45-degree field of view. 1932 x 1910 pixels — 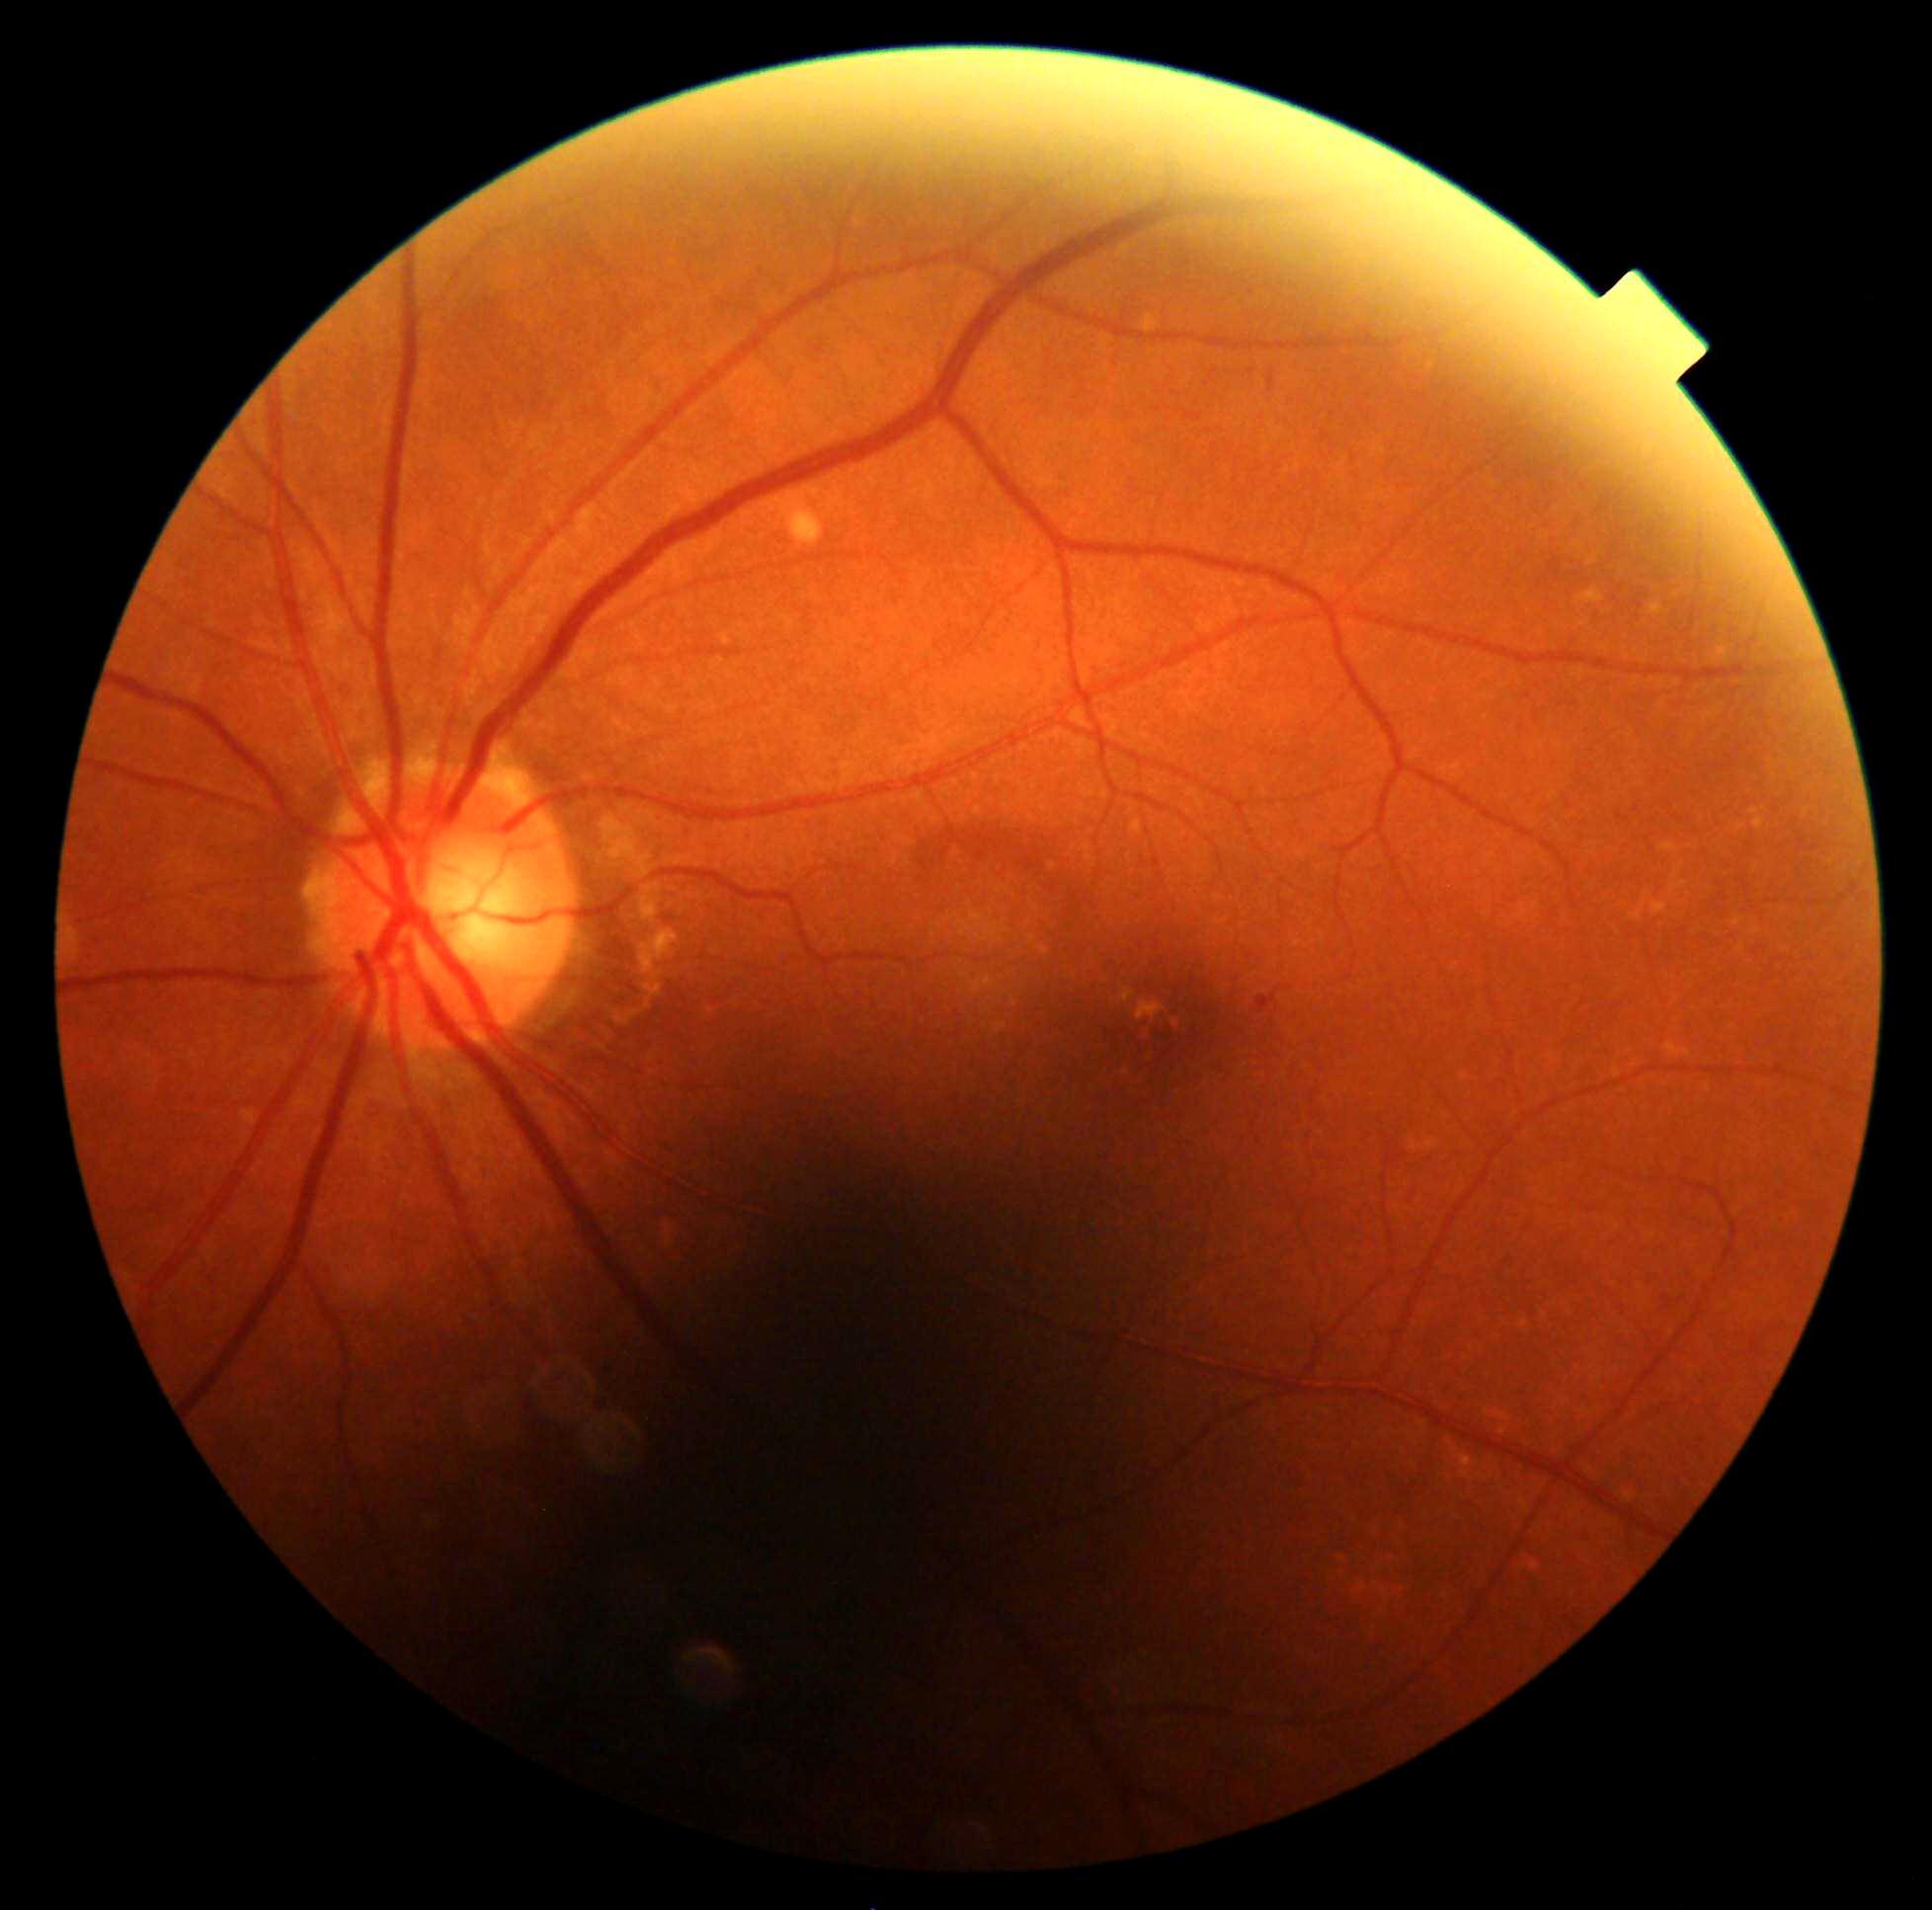 Diabetic retinopathy grade: 1 (mild NPDR).